Color fundus photograph from a handheld portable camera · 2212 by 1659 pixels · 60-degree field of view:
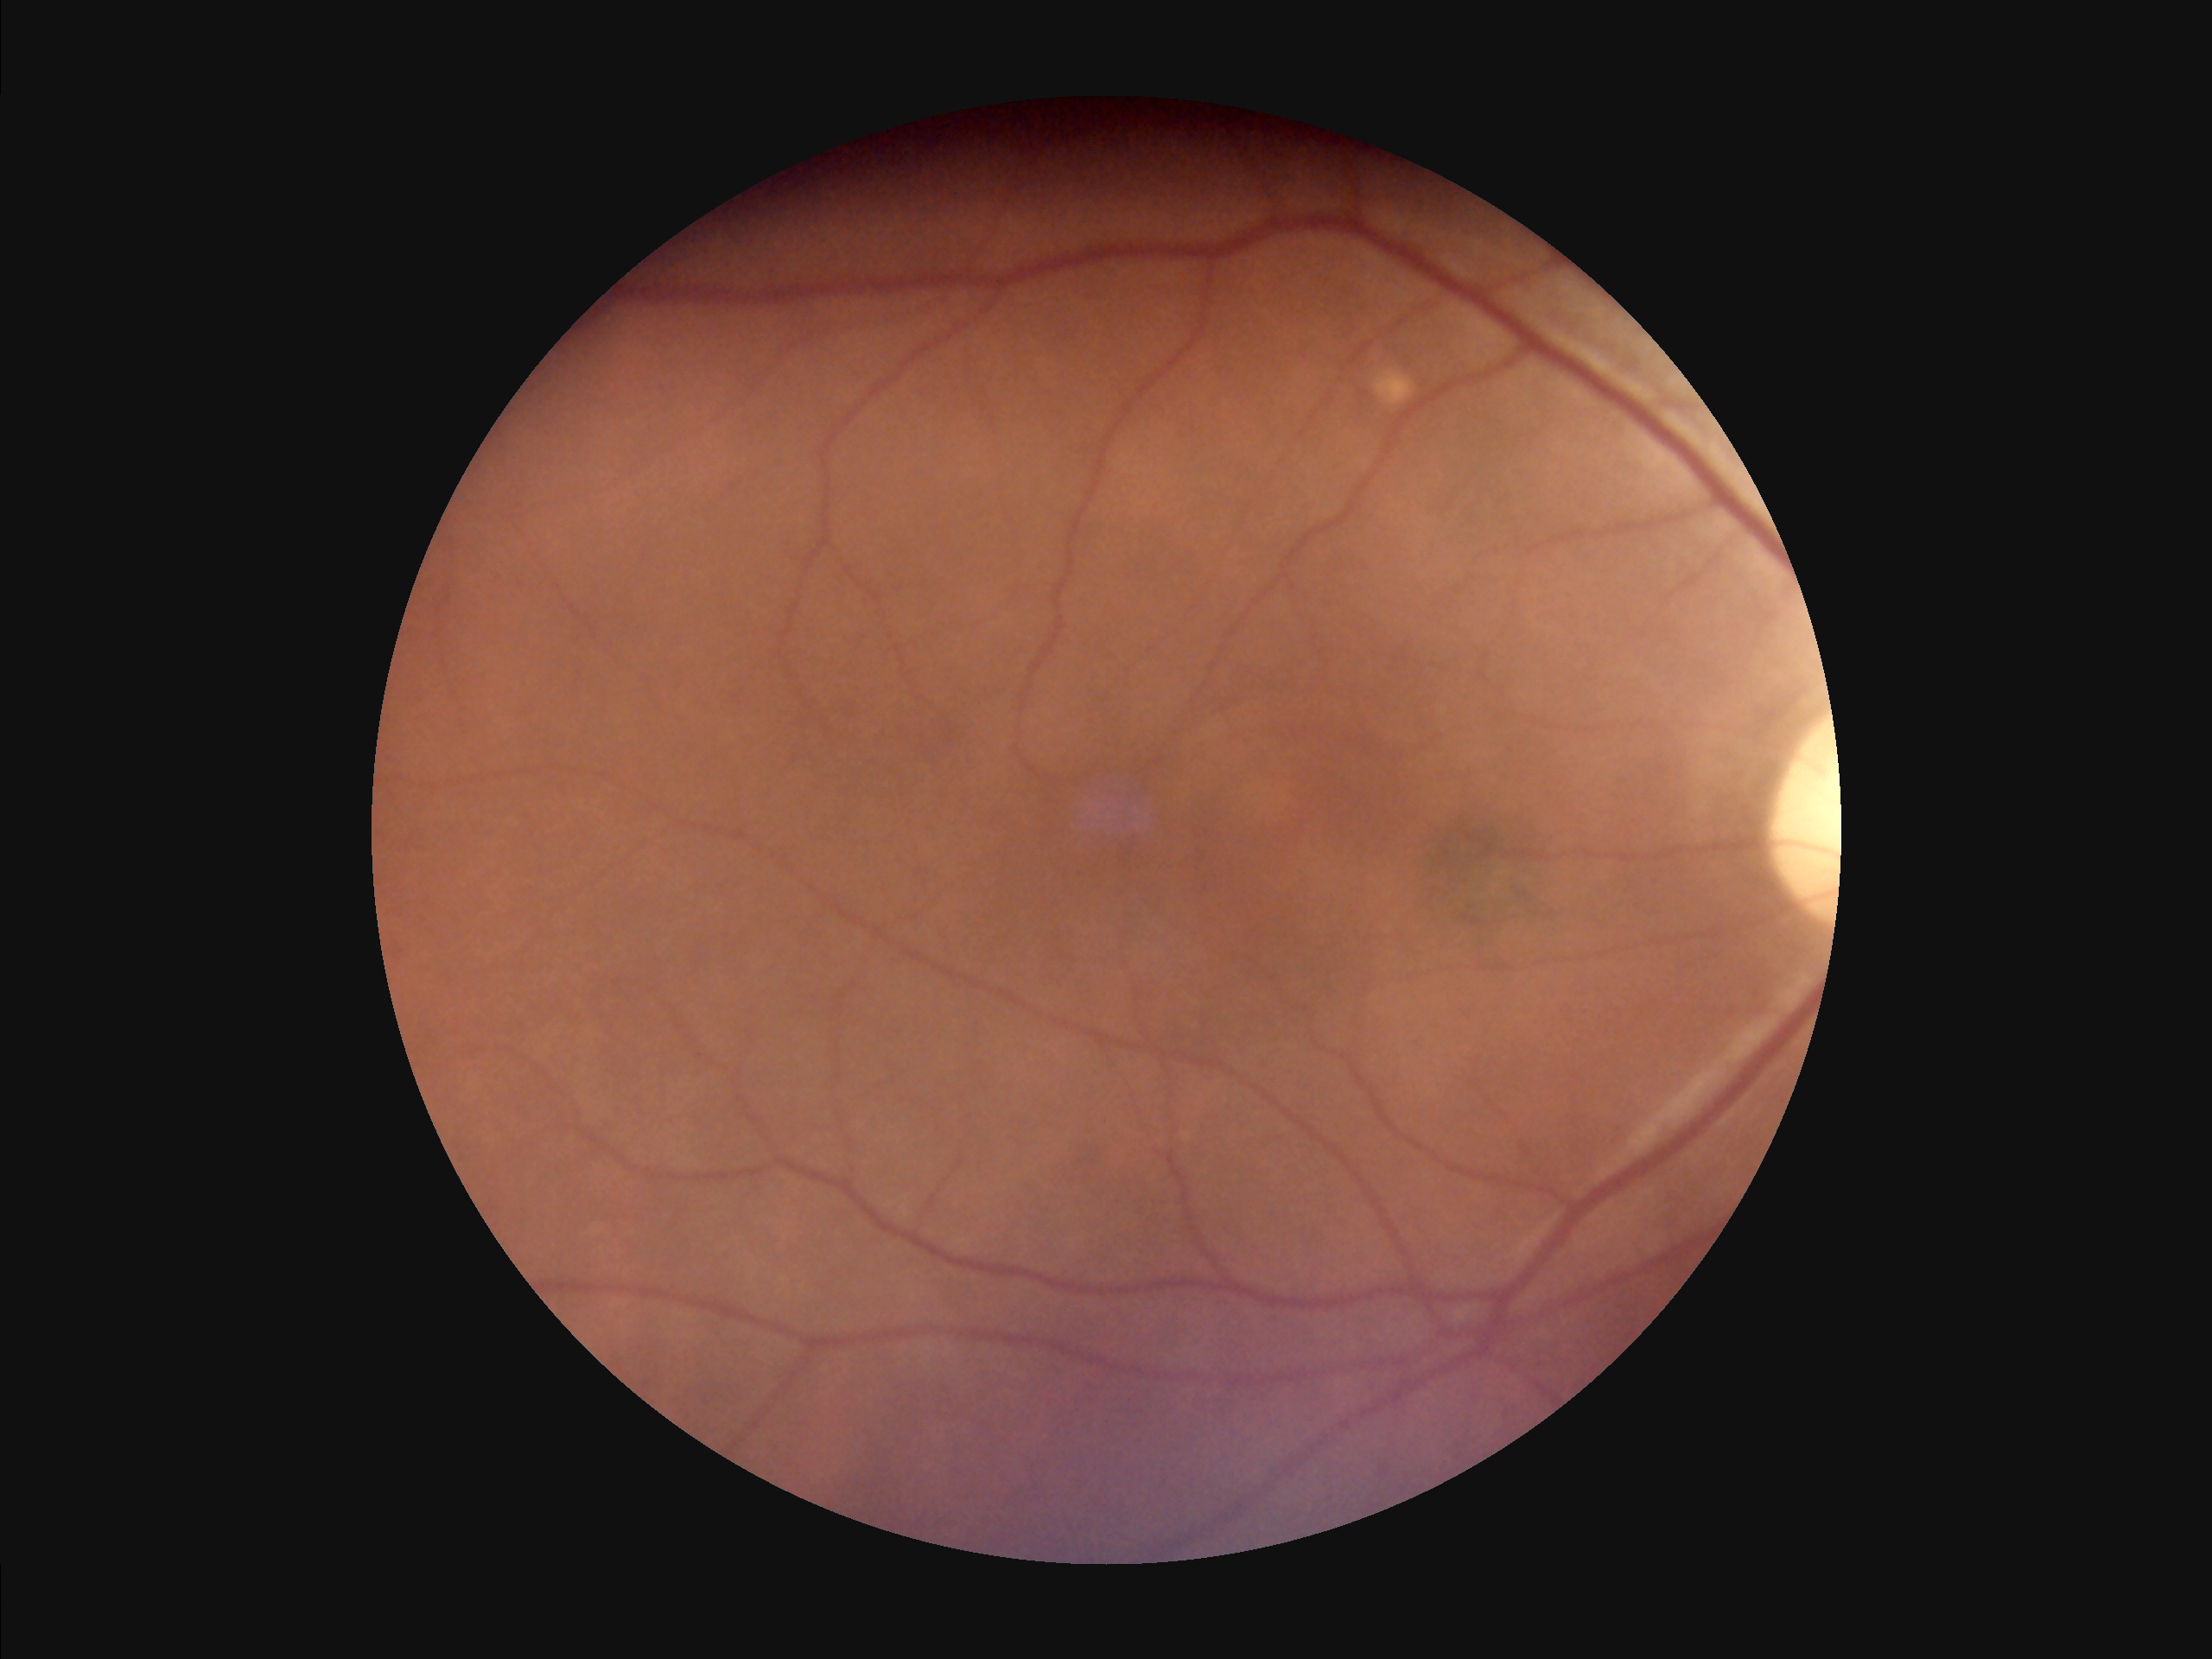
Overall image quality: adequate for clinical interpretation | Contrast: vessels and details readily distinguishable | Illumination/color: even and well-balanced | Focus: out of focus, structures indistinct.